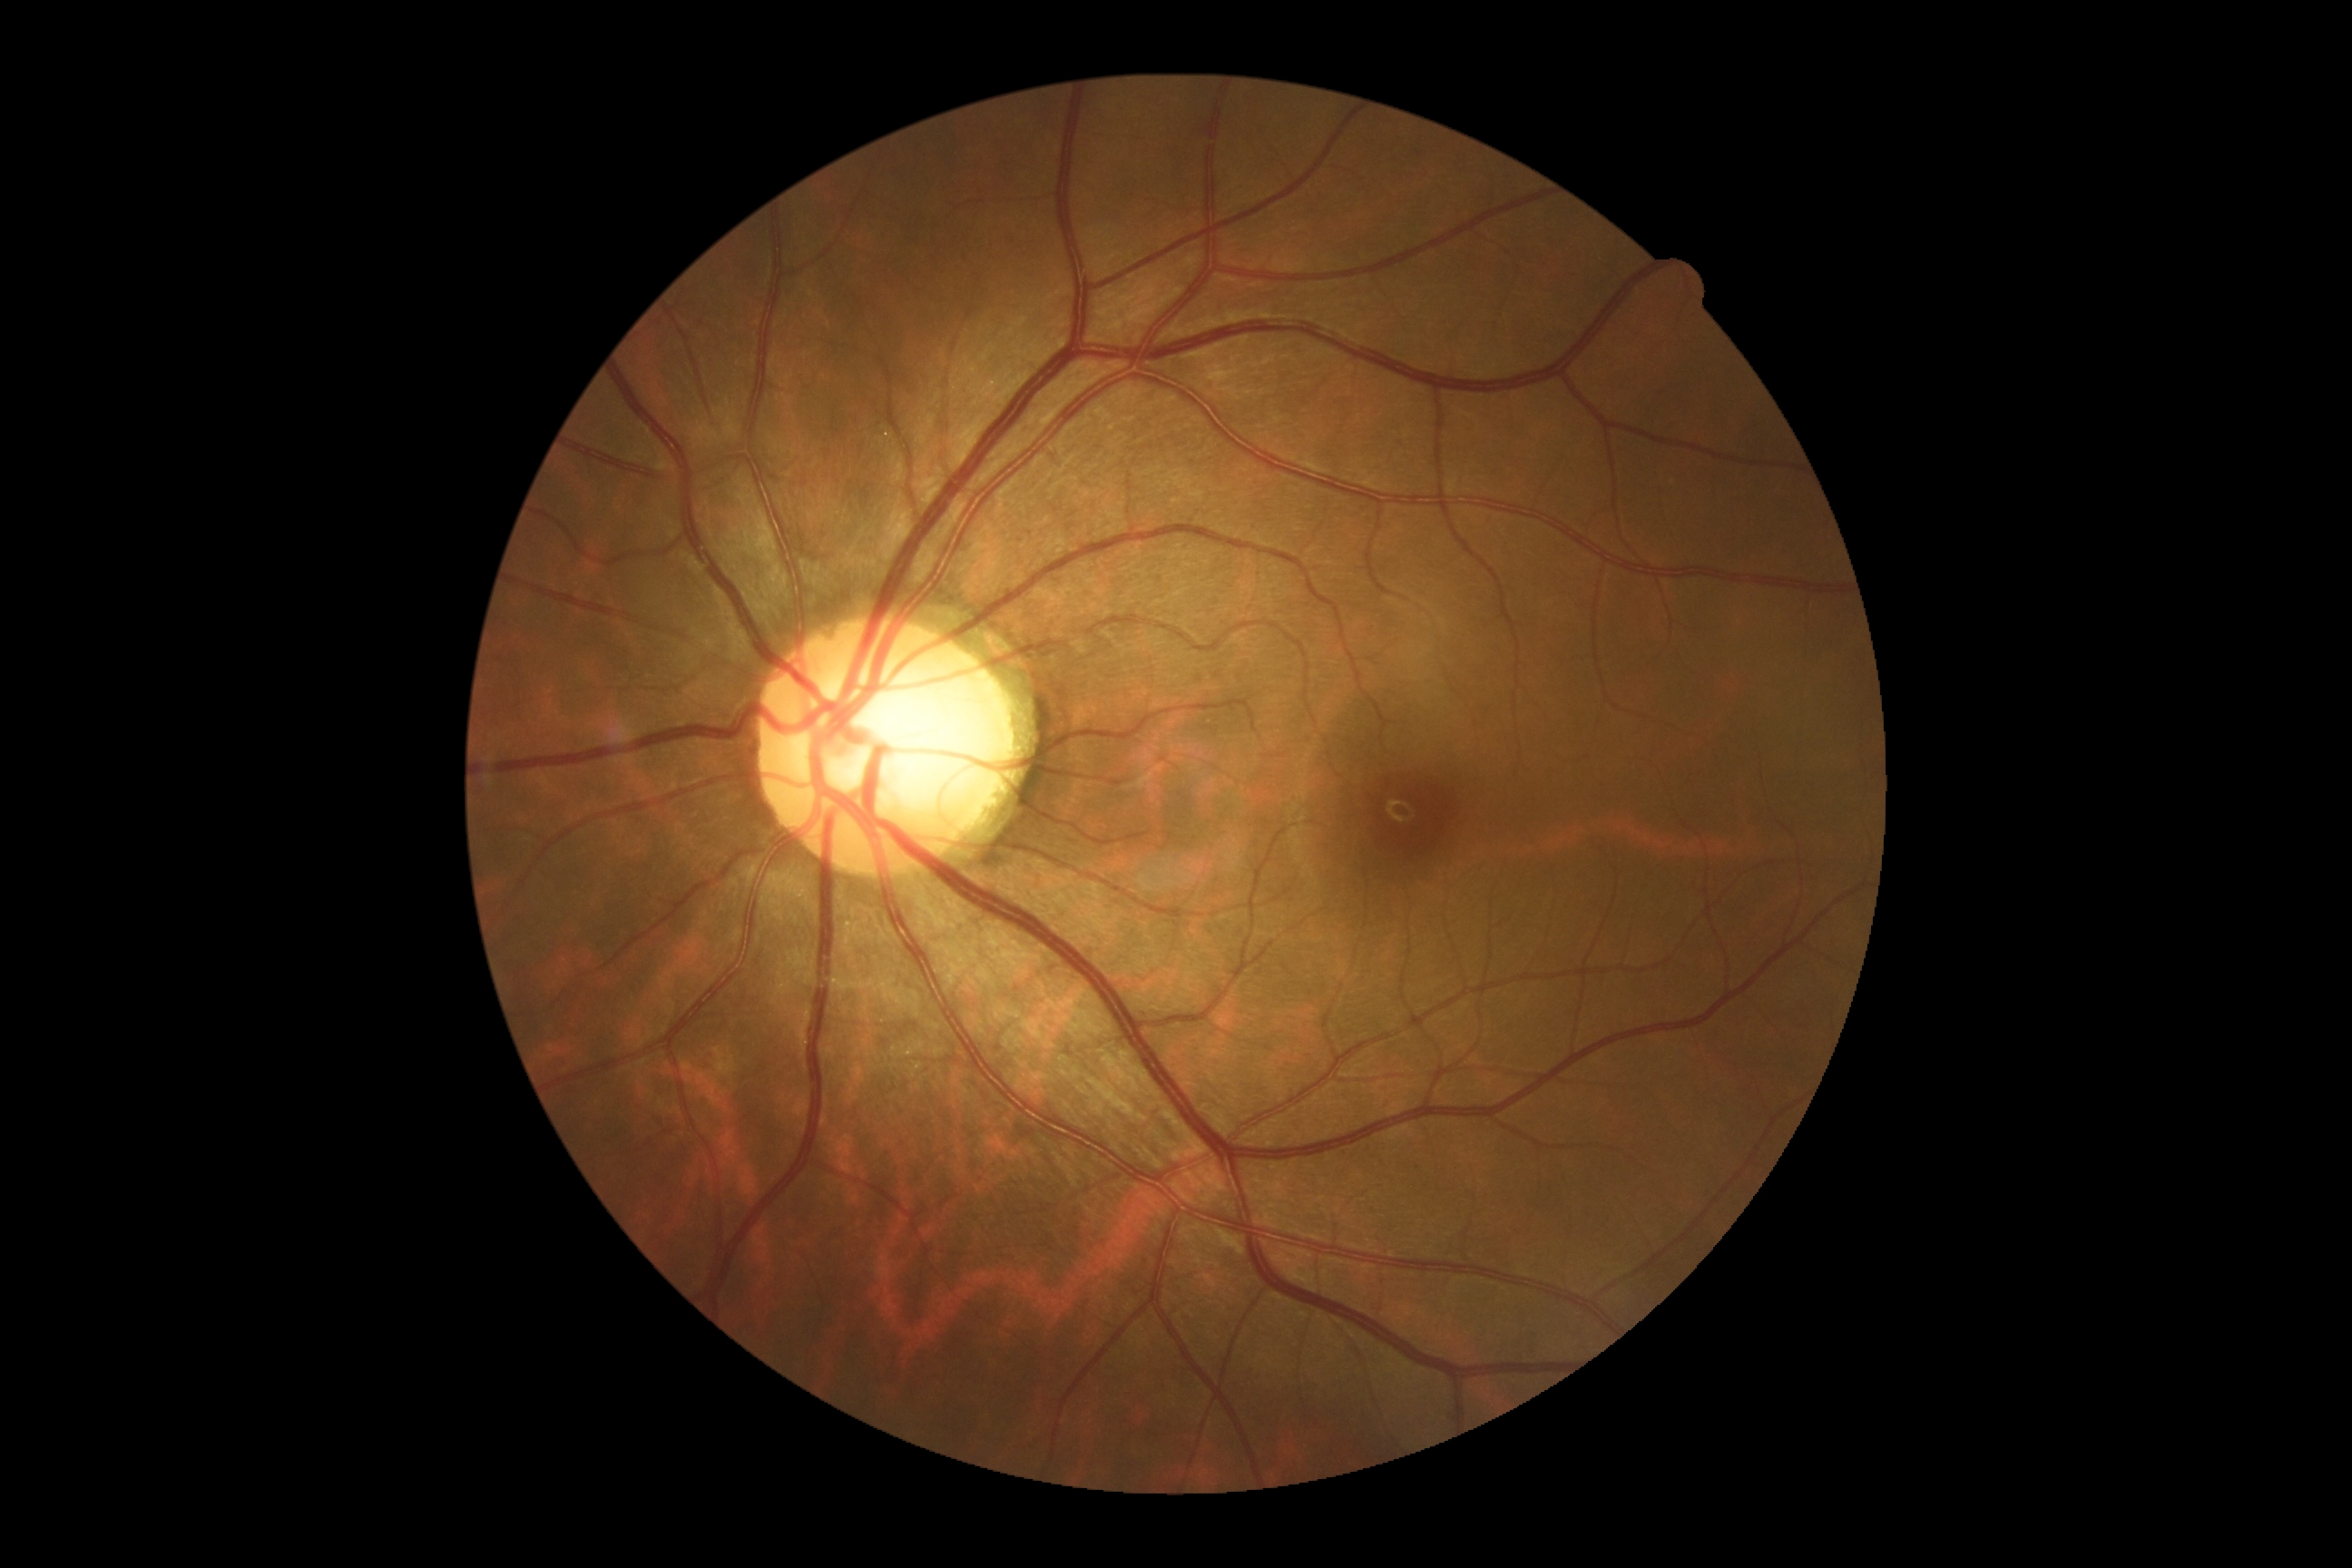 DR severity: grade 0.